Camera: NIDEK AFC-230. 45° FOV. Color fundus image. No pharmacologic dilation
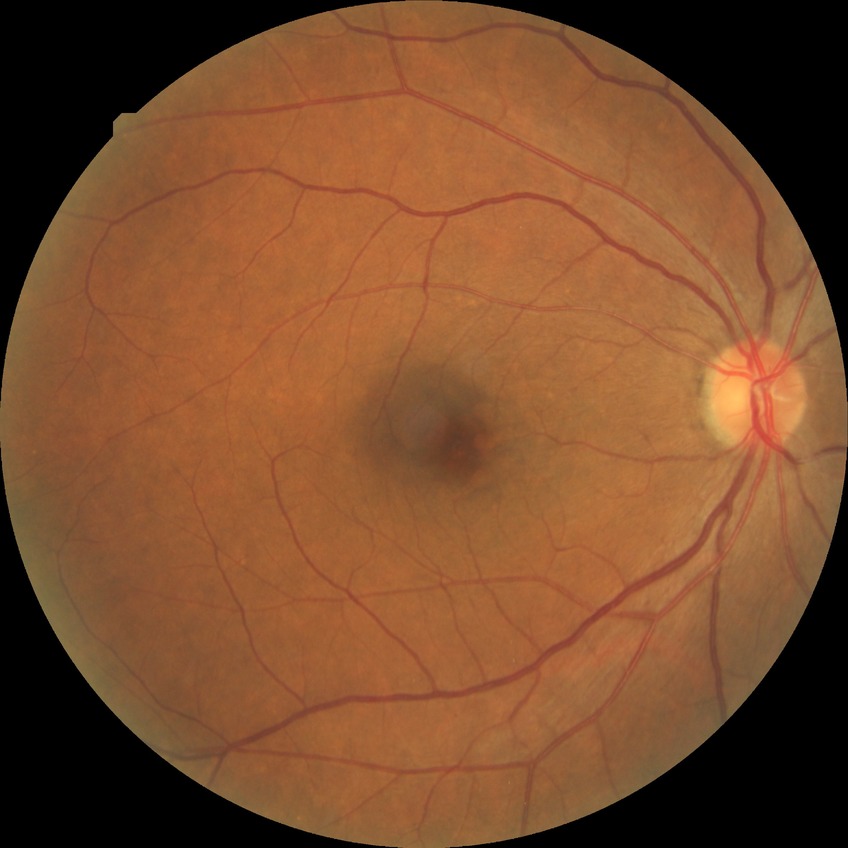 diabetic retinopathy (DR): SDR (simple diabetic retinopathy).